Wide-field contact fundus photograph of an infant. 1240x1240px — 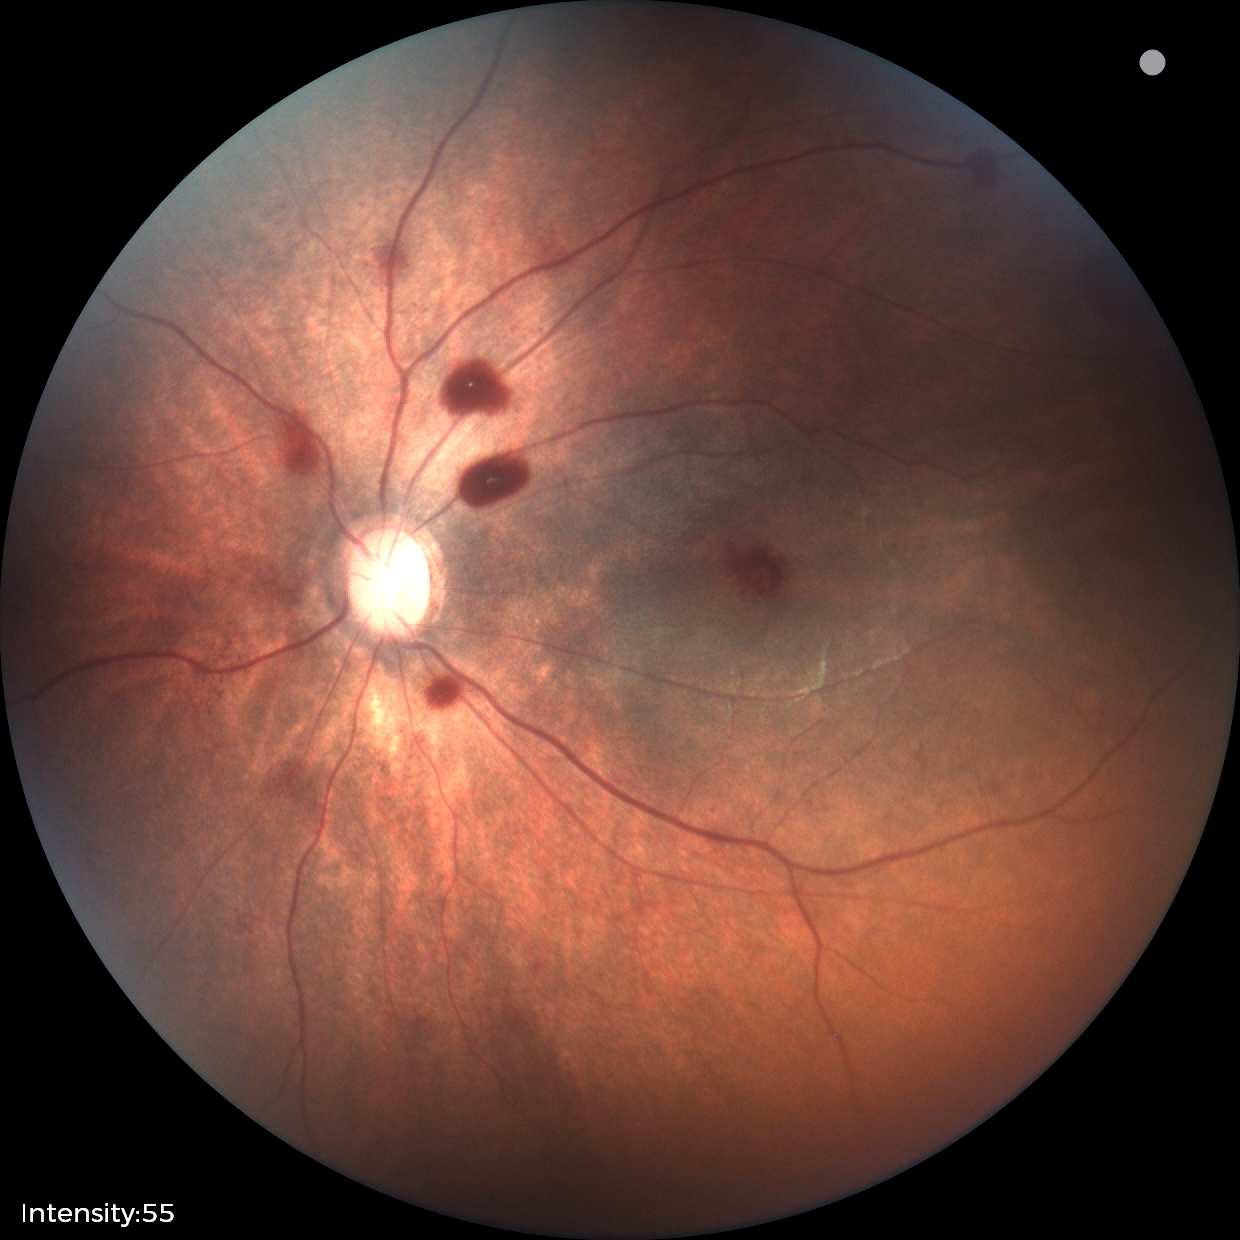
Screening series with retinal hemorrhages.